Color fundus image; 2228 x 1652 pixels: 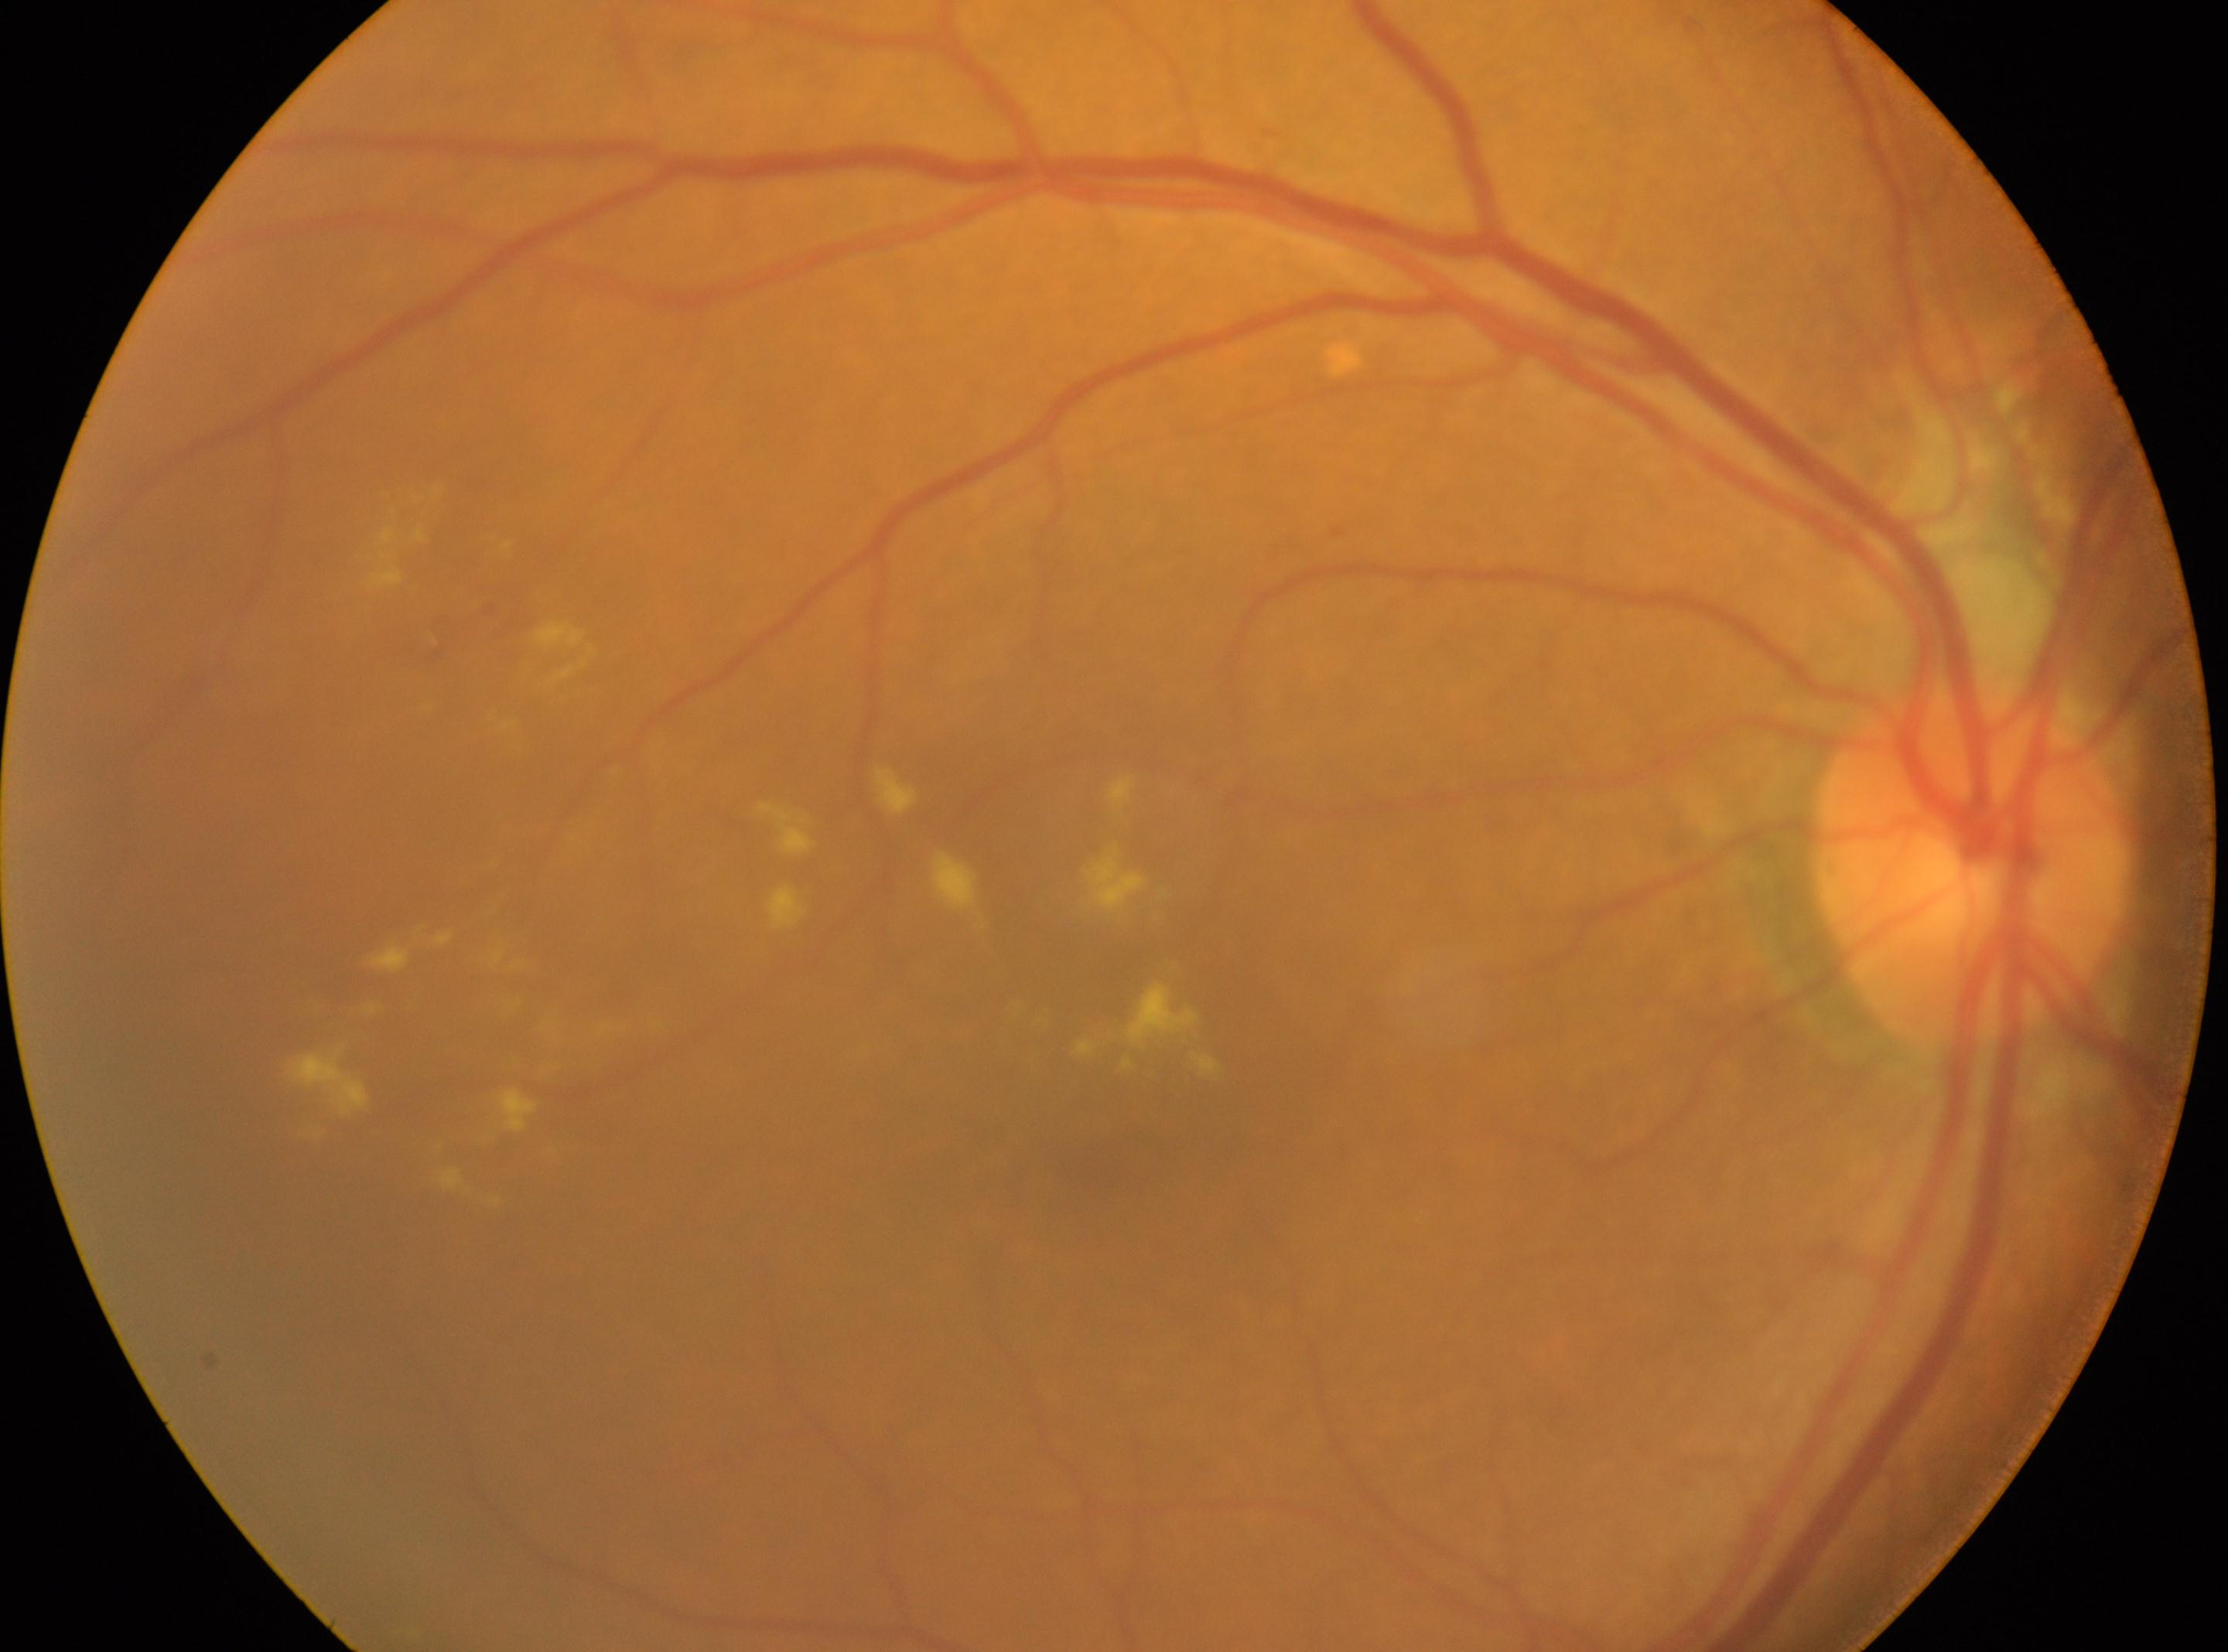 Q: Where is the optic disc?
A: (1972,868)
Q: DR stage?
A: 2
Q: Fovea center?
A: (1154,1104)
Q: Which eye is imaged?
A: the right eye